45° field of view; color fundus photograph
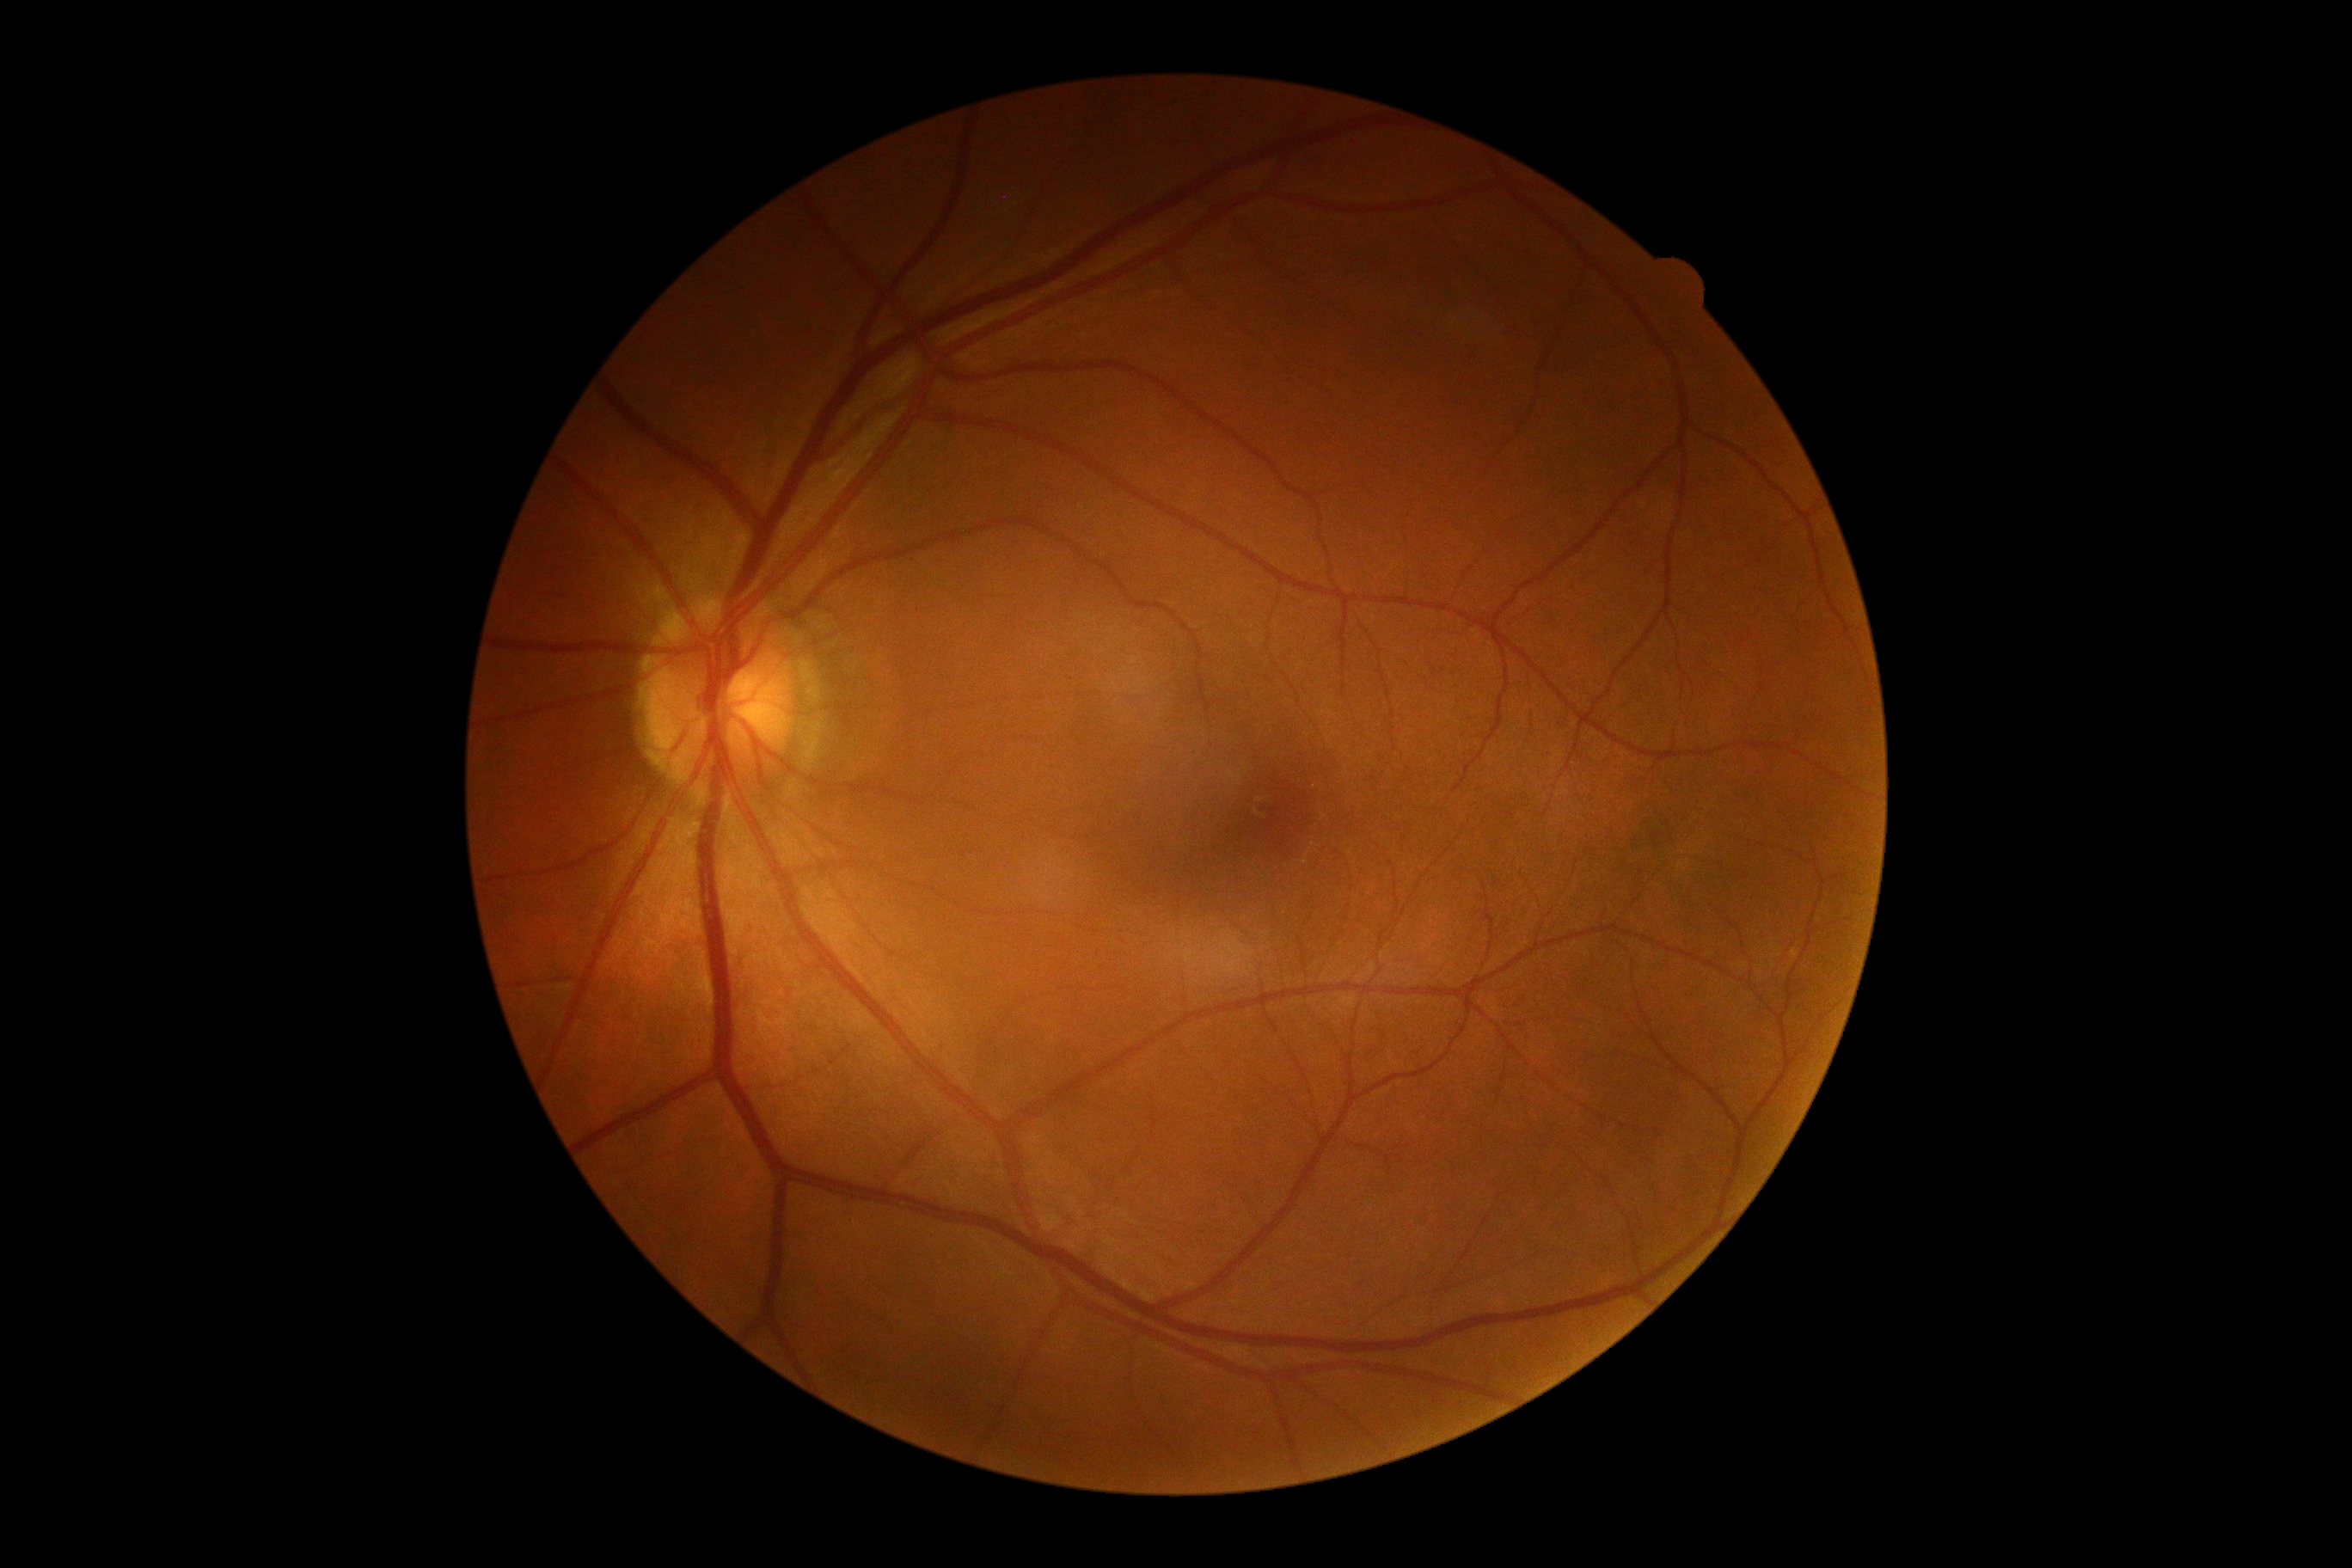
DR stage is 0/4. No signs of diabetic retinopathy.